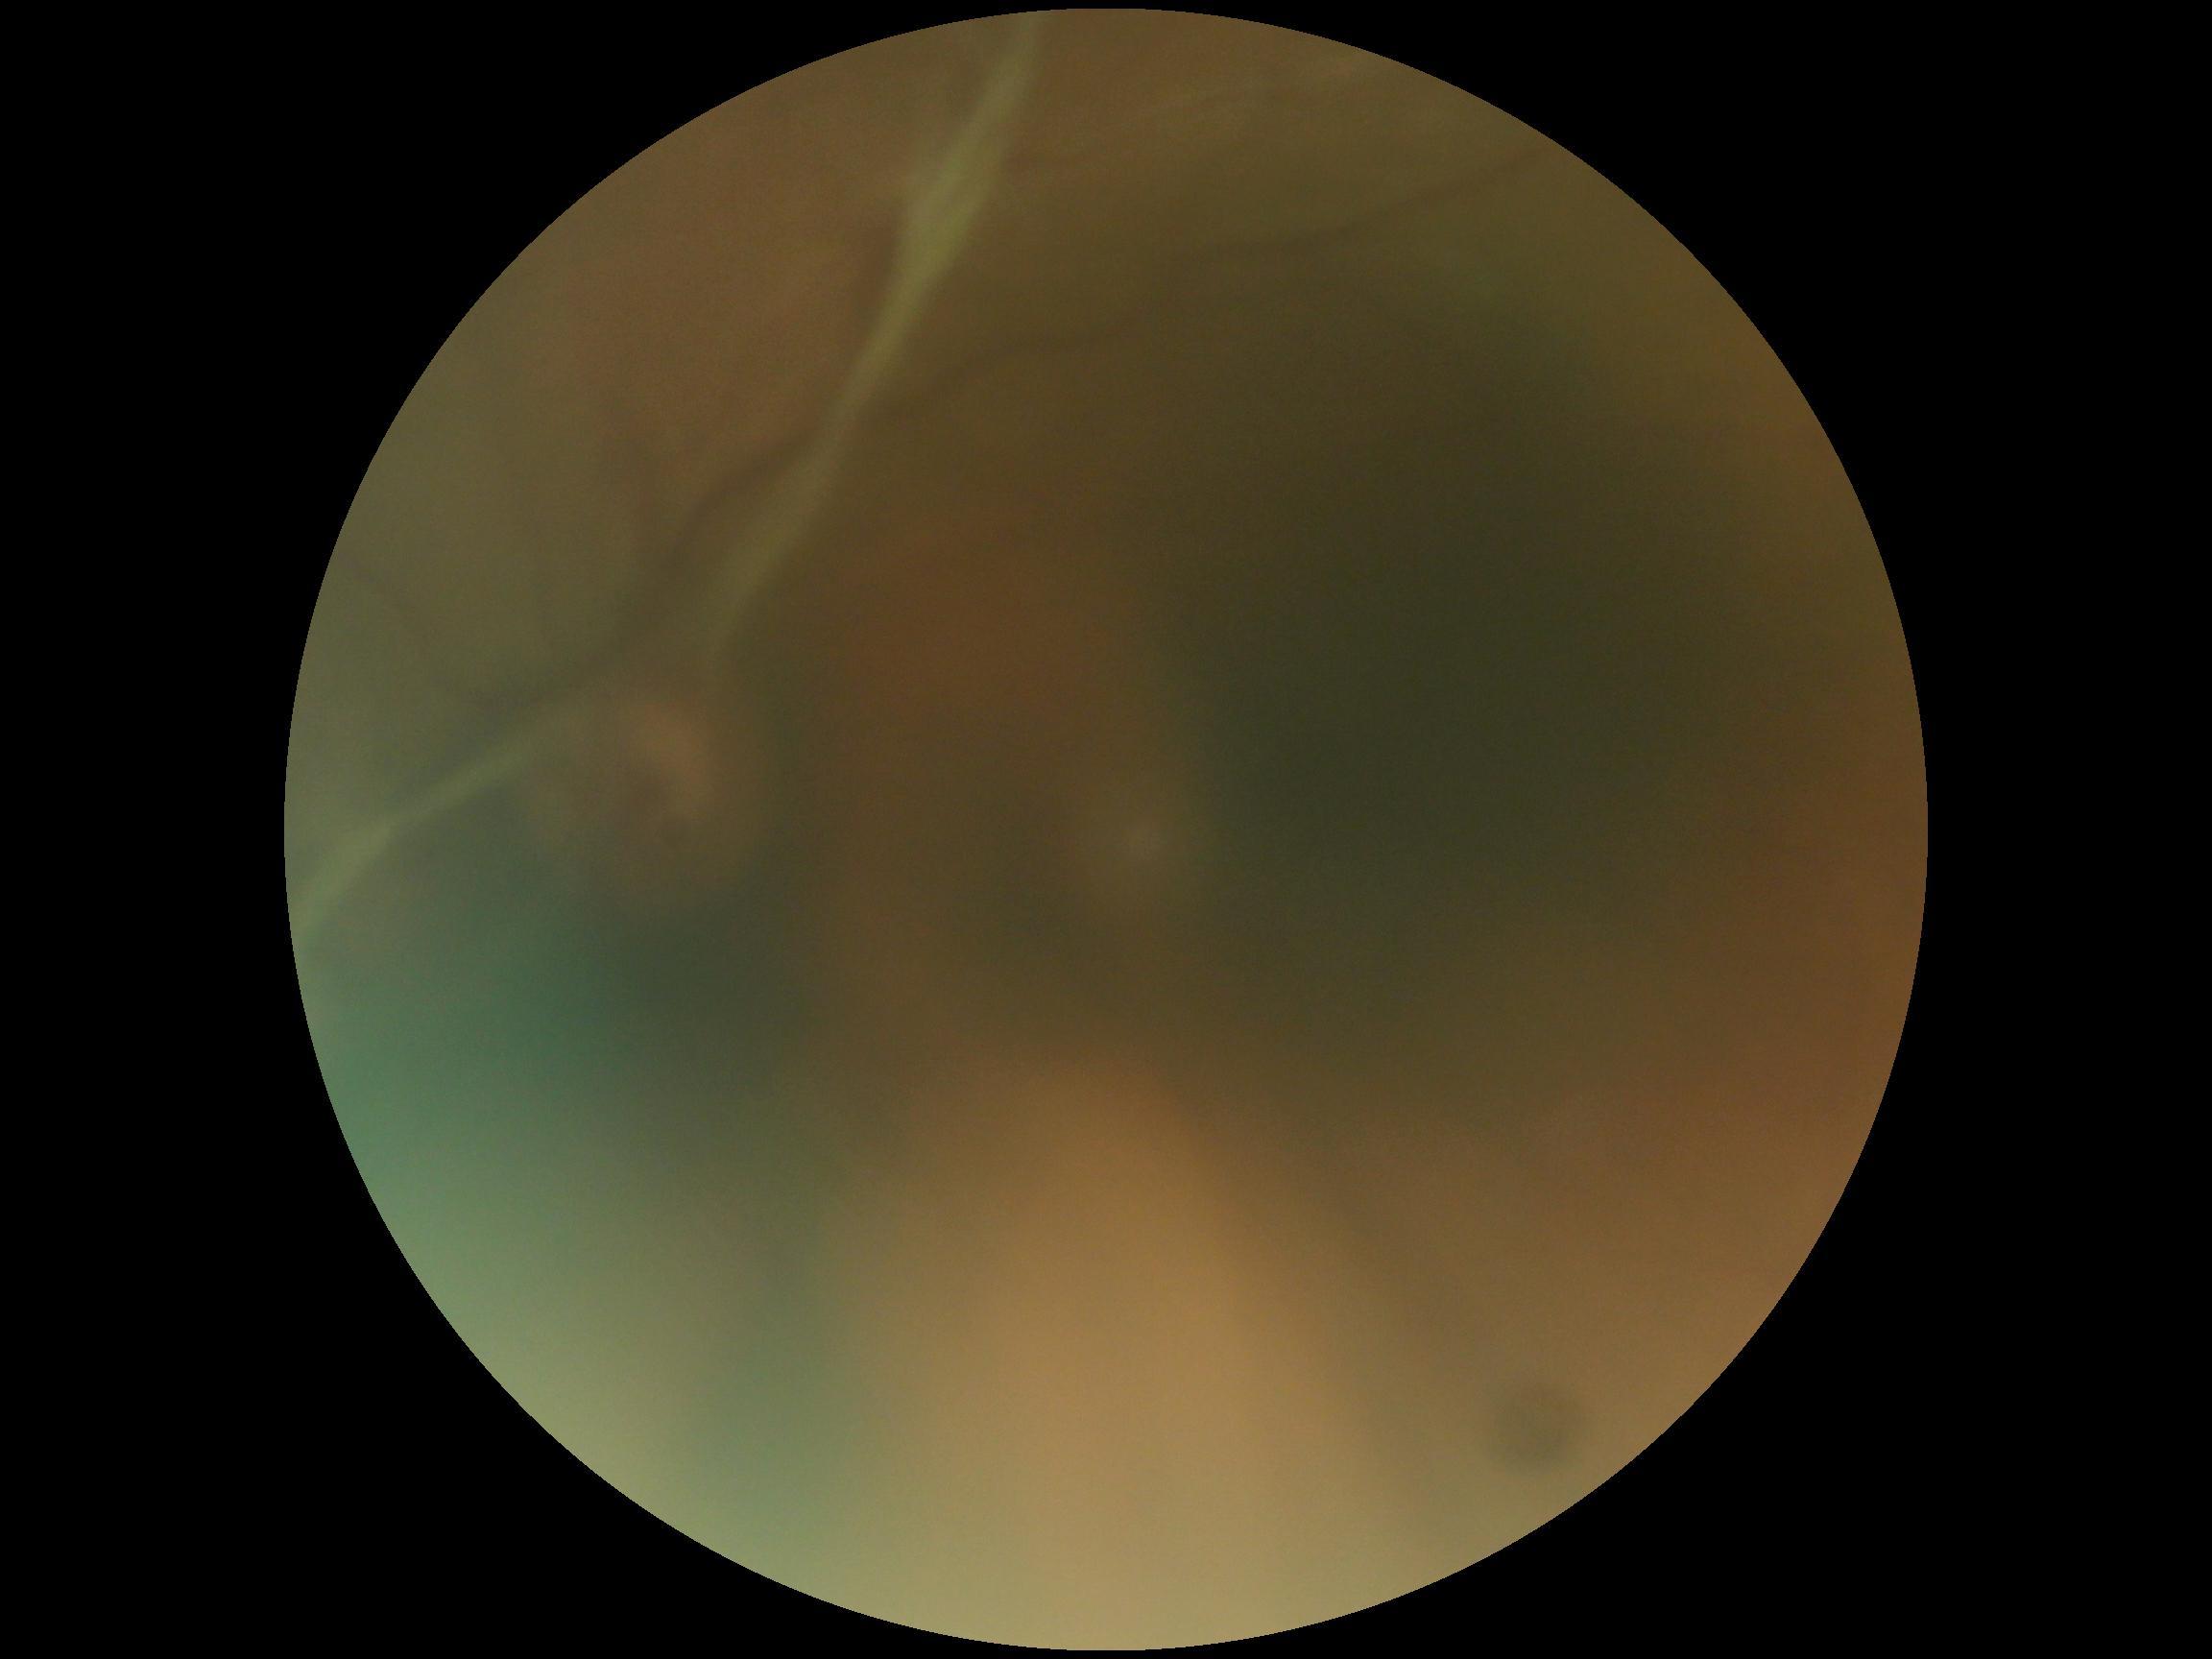

Diabetic retinopathy grade: 4.